100° field of view (Phoenix ICON) · wide-field fundus photograph of an infant: 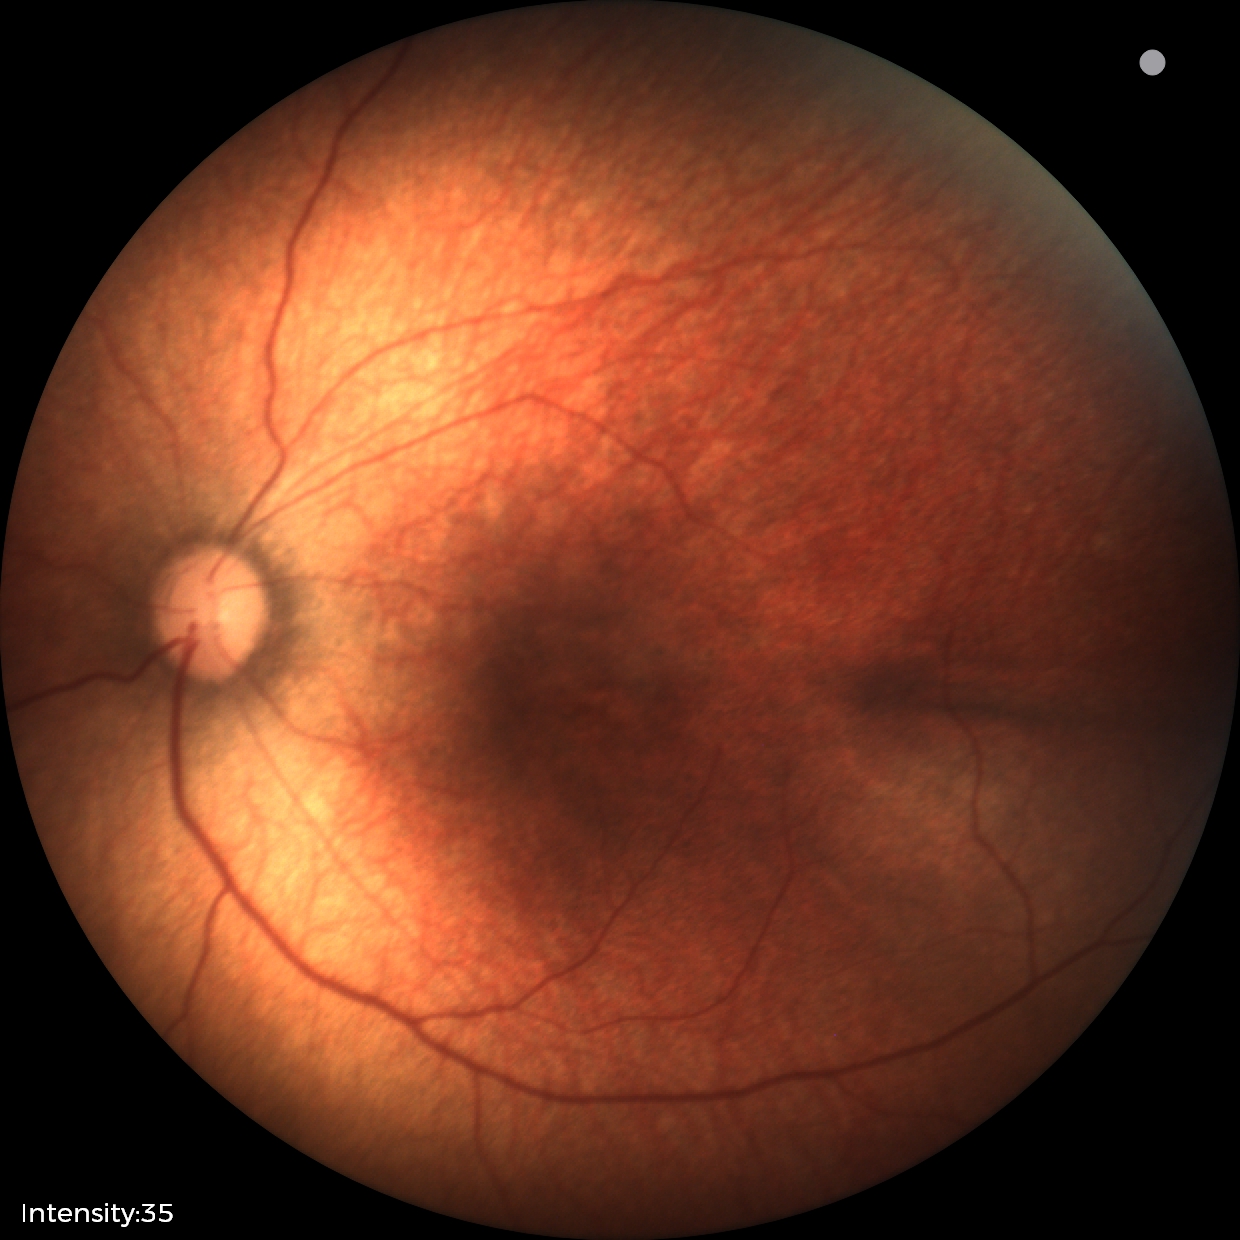
Screening: physiological retinal finding.